Fundus photo — 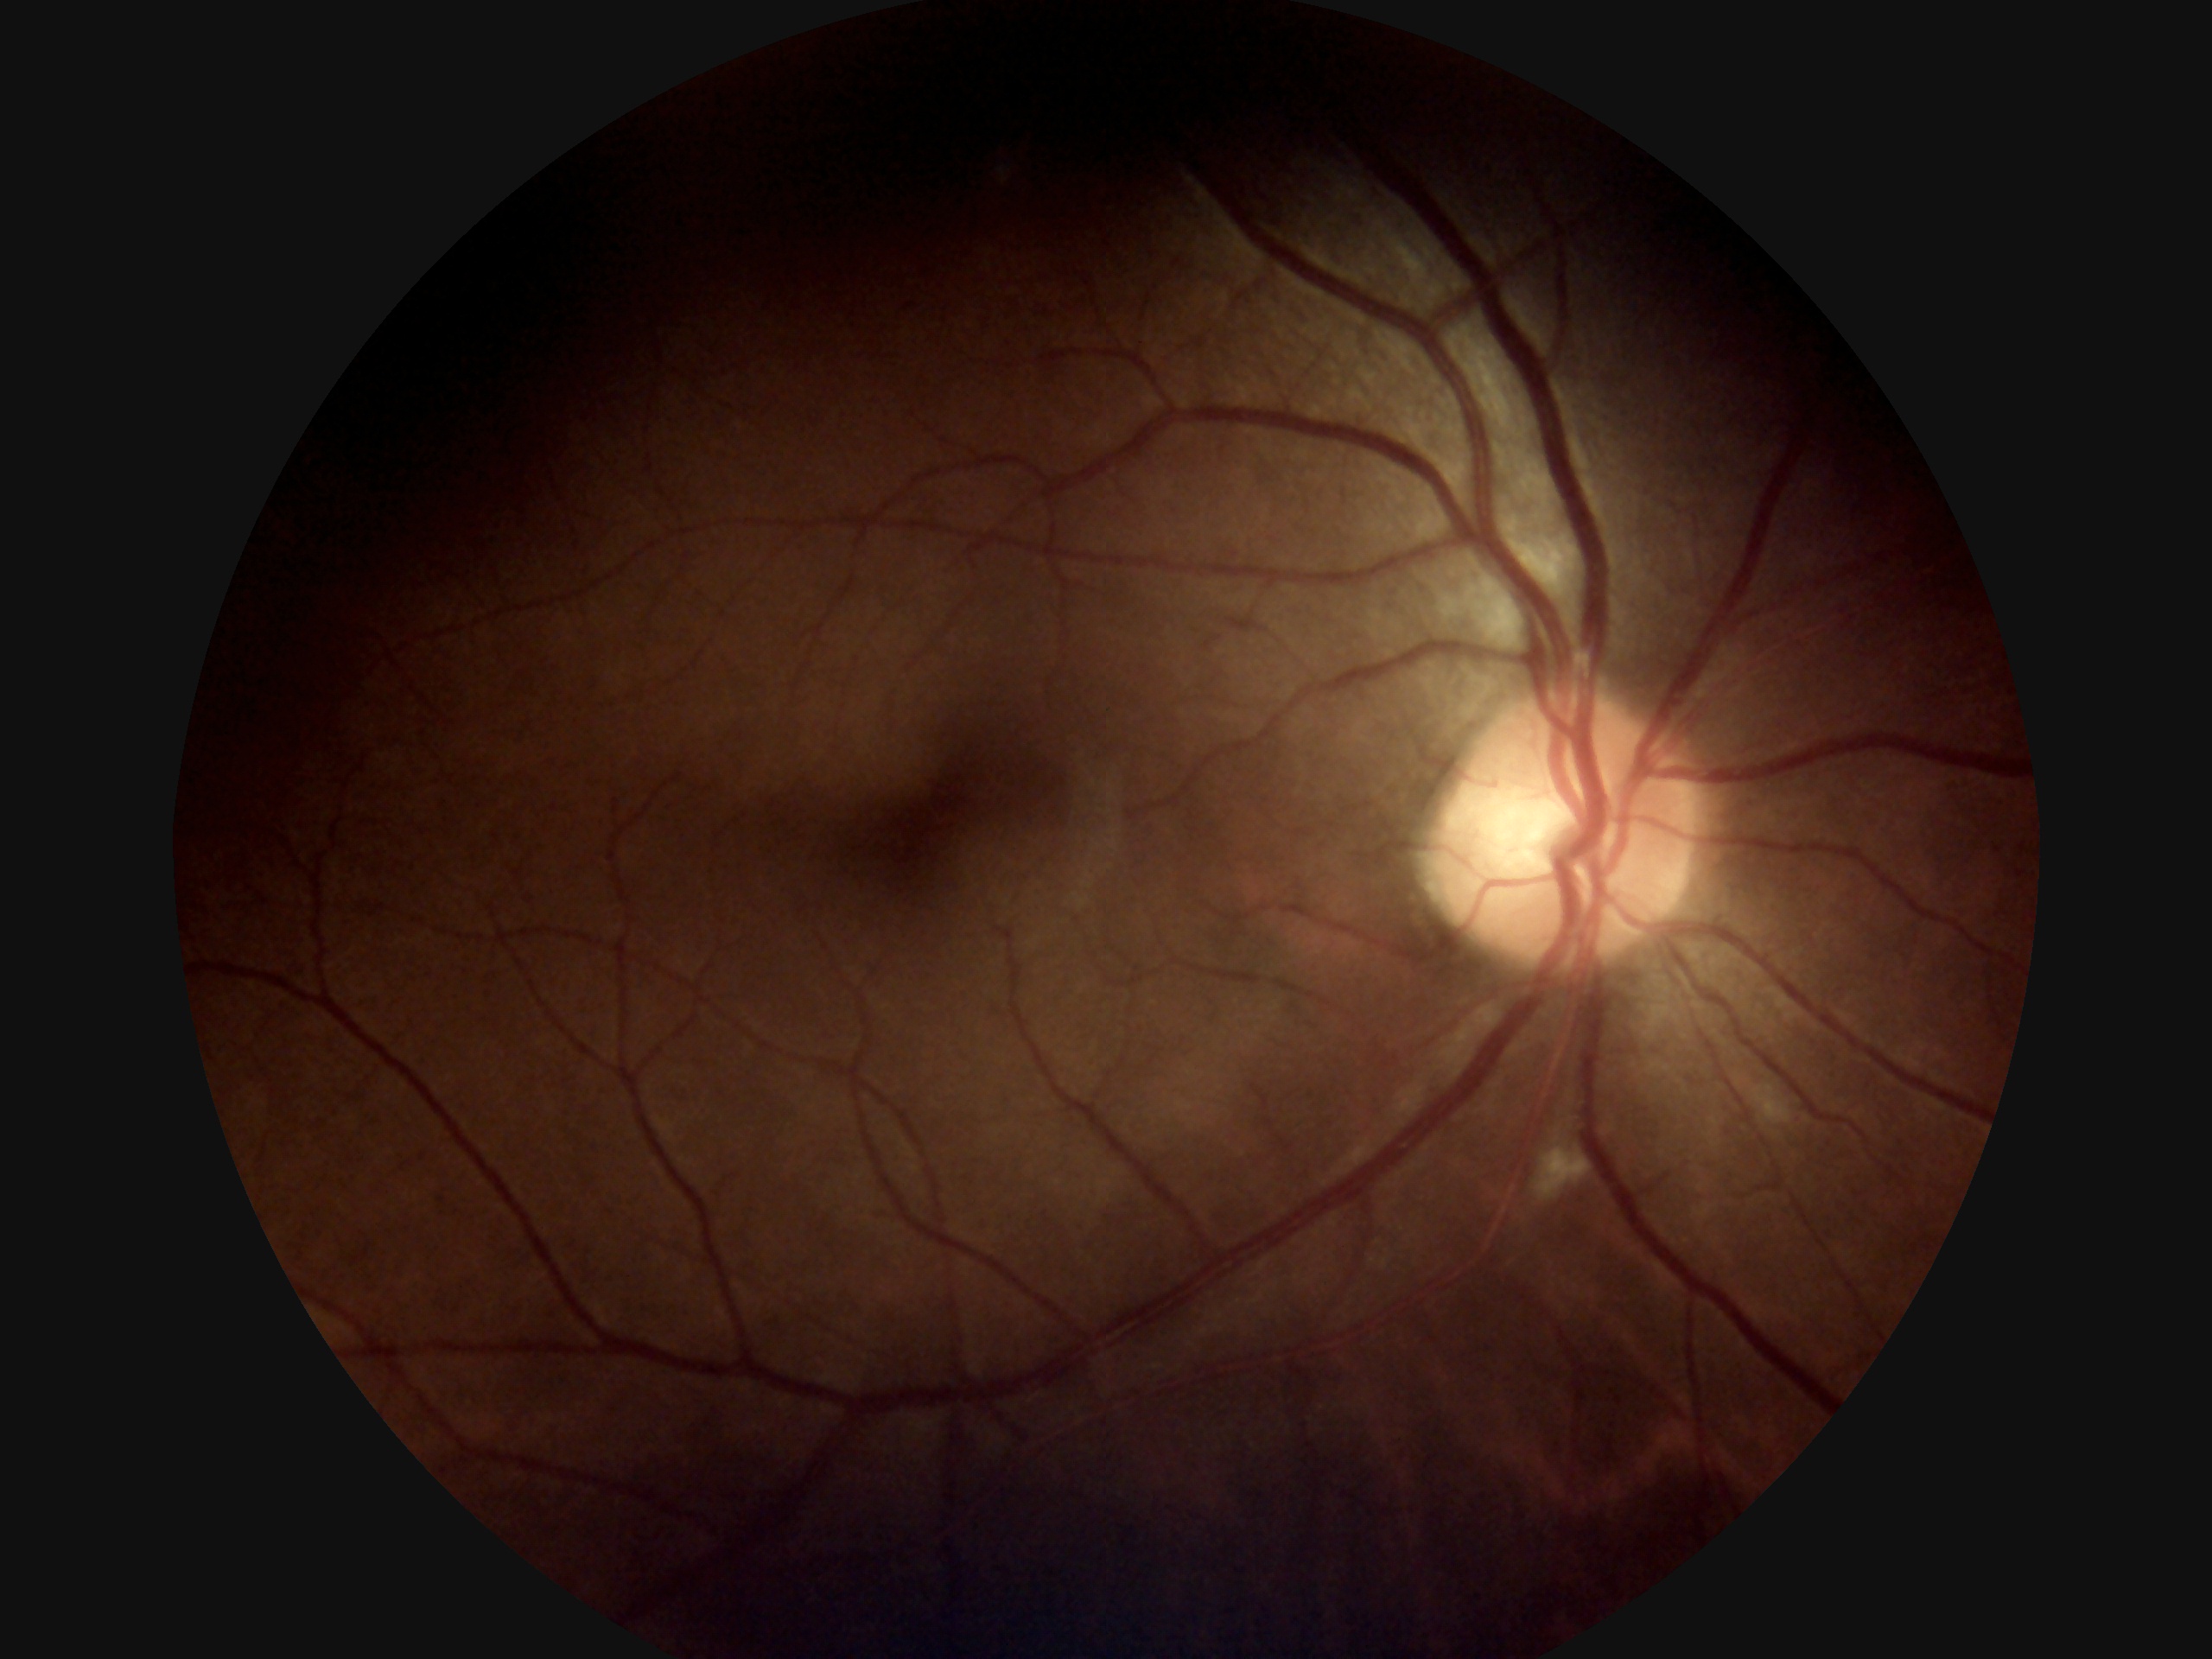
DR grade is moderate NPDR (2) — more than just microaneurysms but less than severe NPDR.